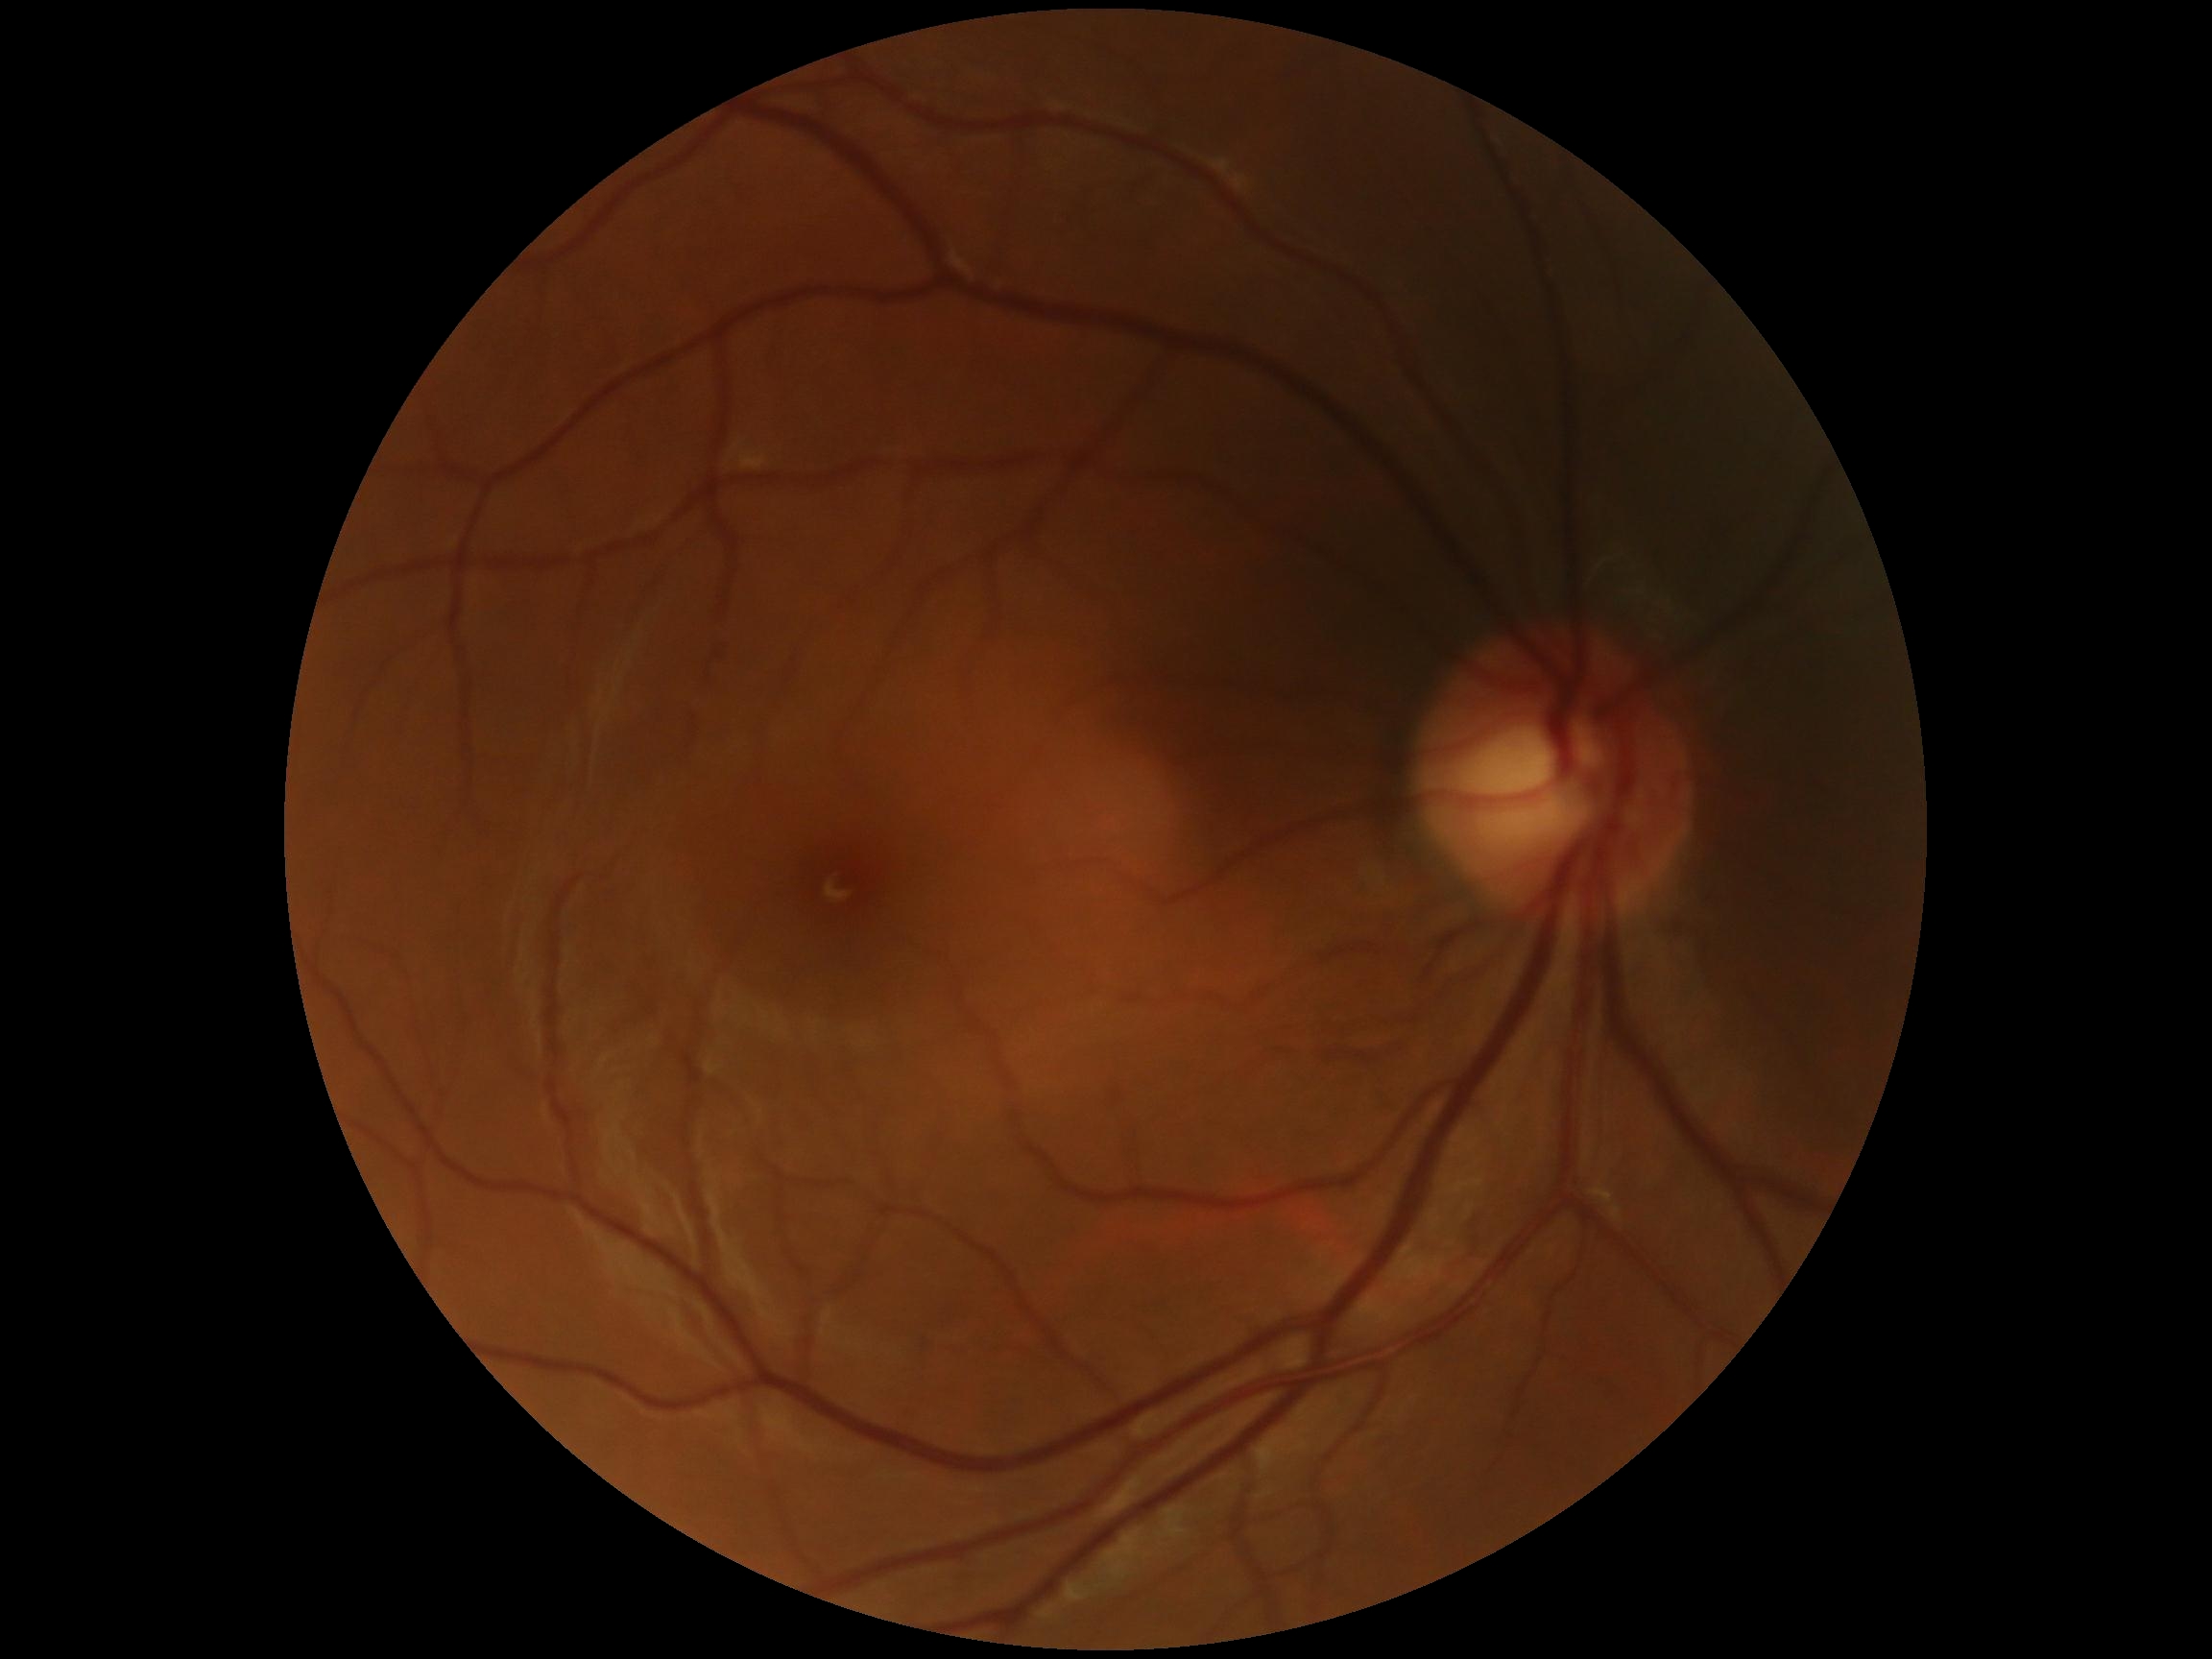 Retinopathy grade is no apparent retinopathy (0).
No diabetic retinal disease findings.